Axial length: 22.84 mm. 2212 by 1661 pixels. Patient age: 67 years. Captured on a Topcon TRC-NW400 fundus camera.
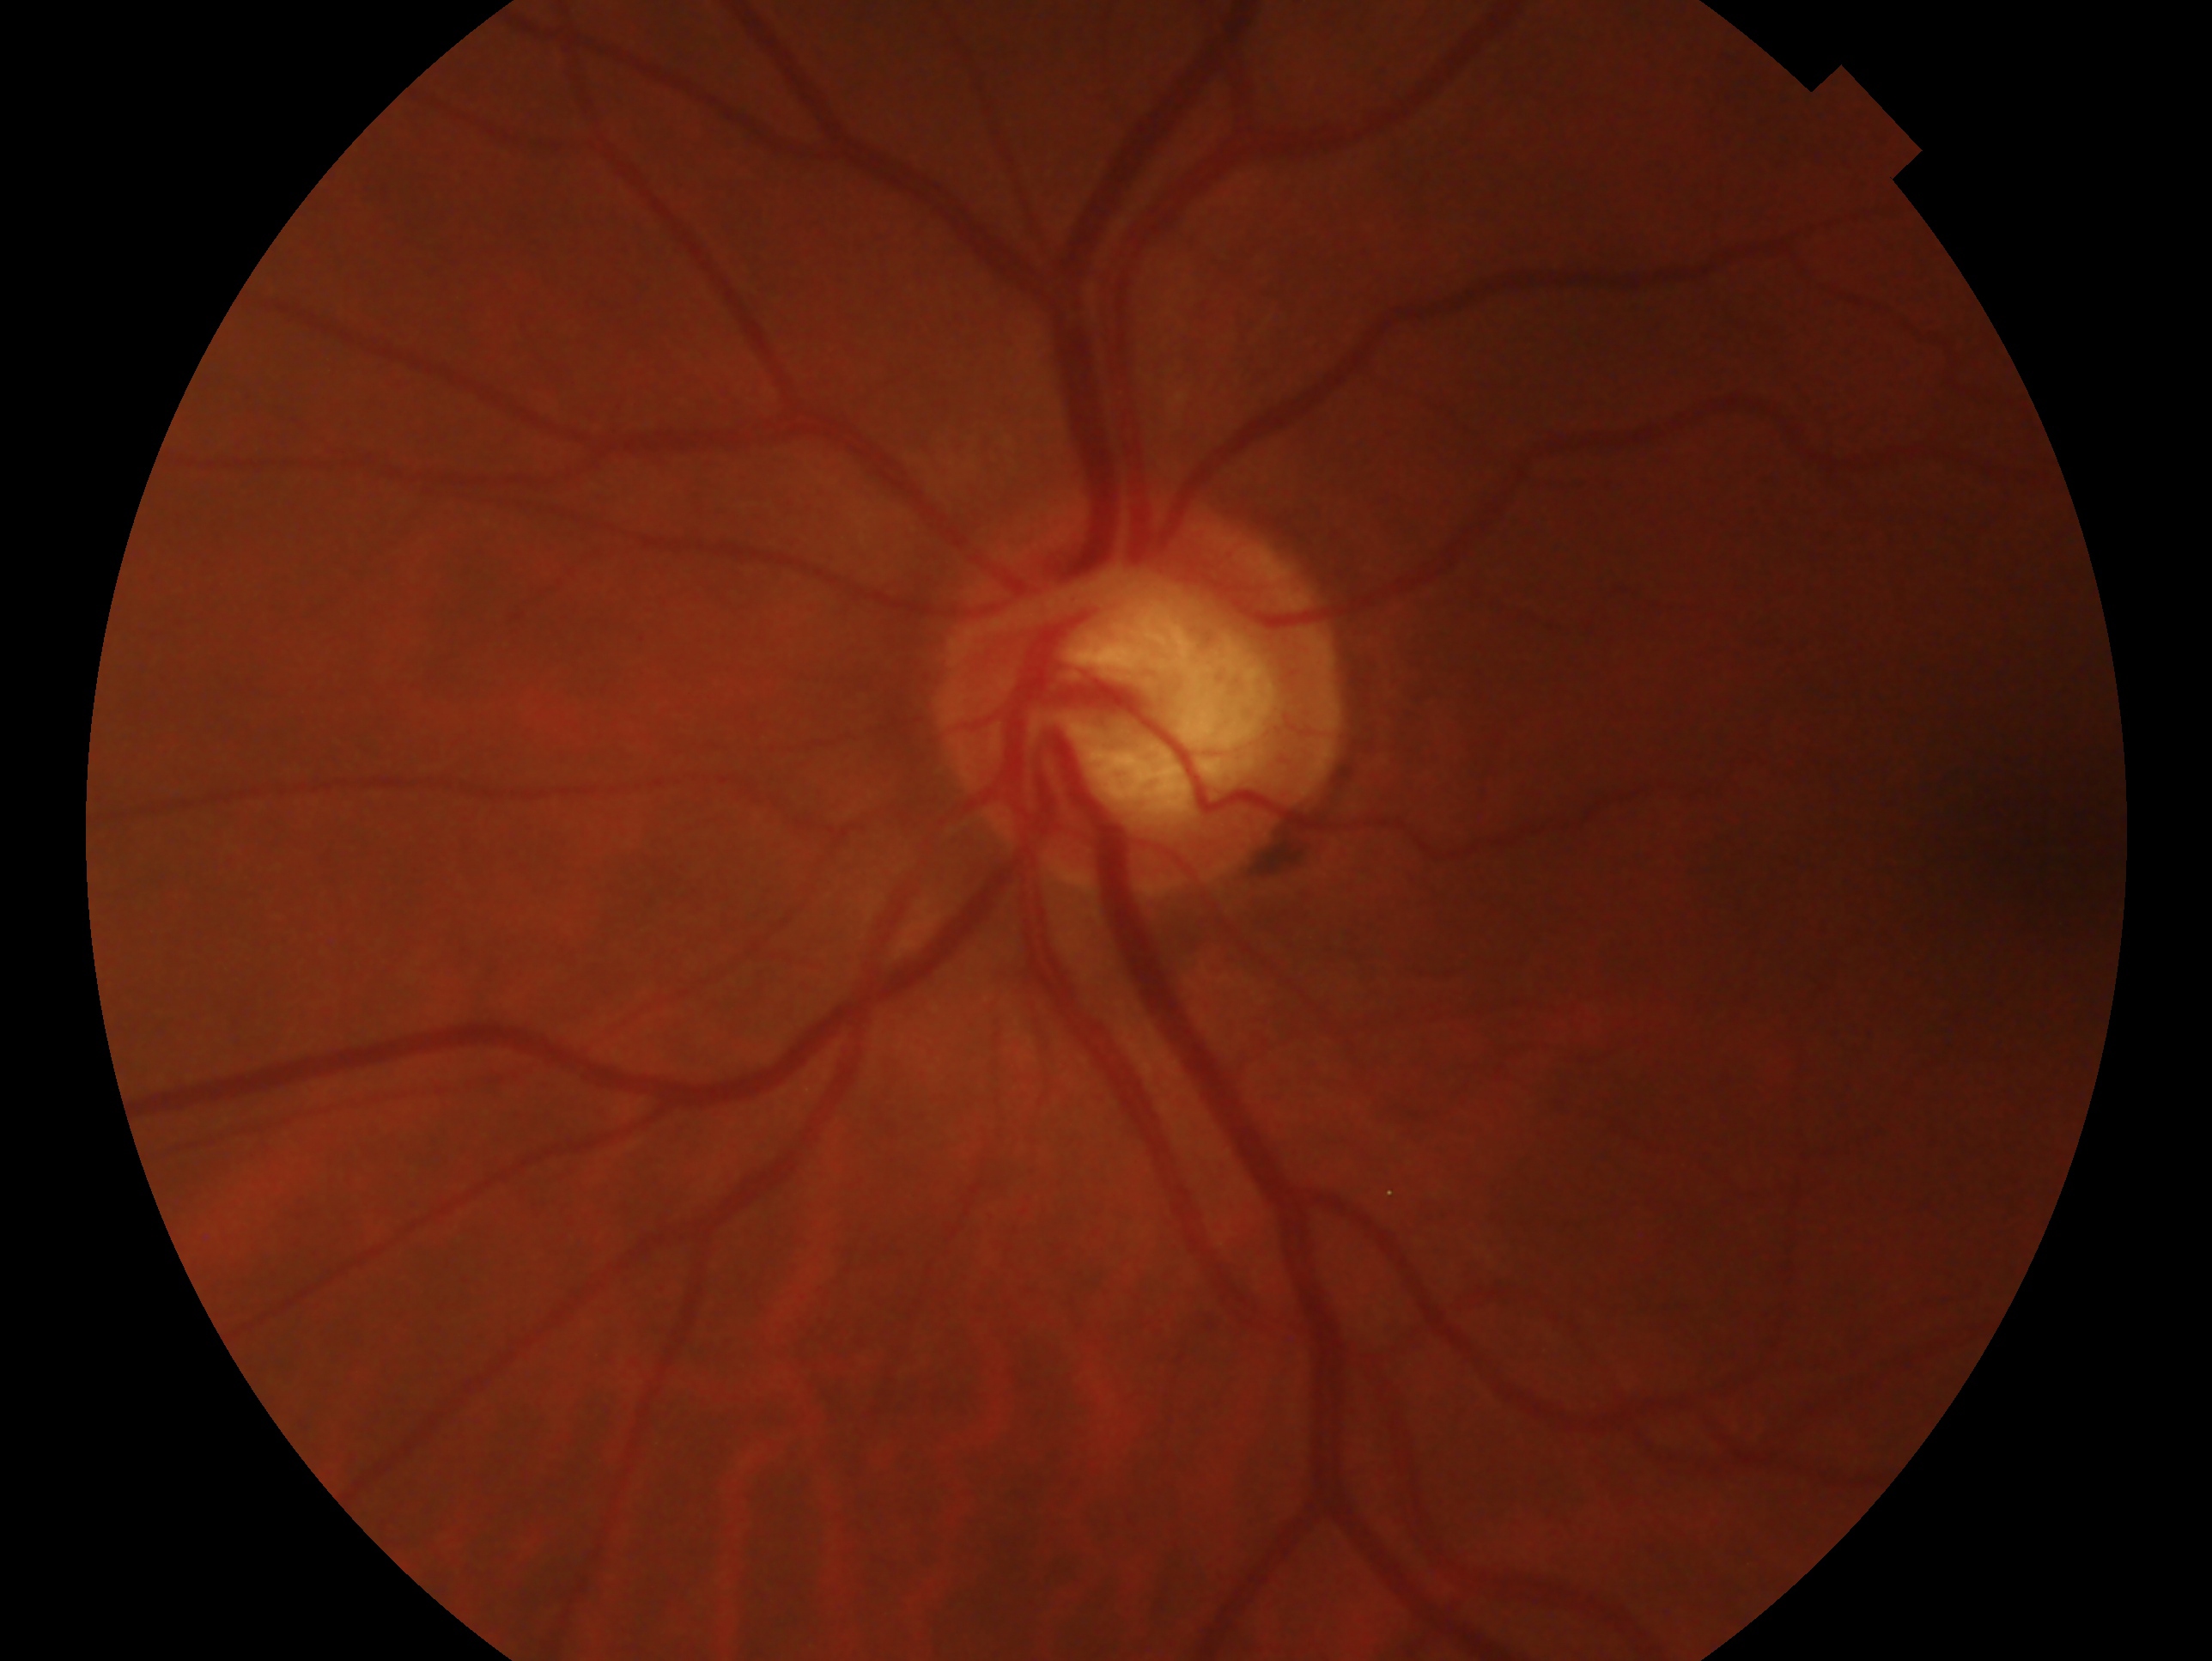
This is the OS. Diagnosis: suspicious for glaucoma.